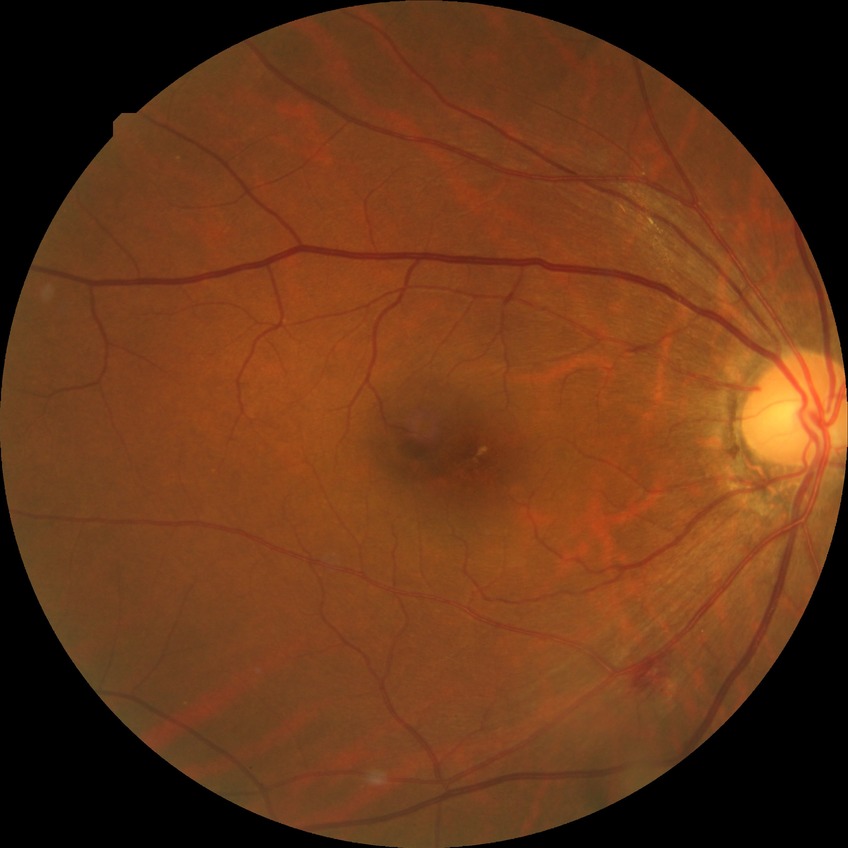 Diabetic retinopathy (DR): NDR (no diabetic retinopathy).